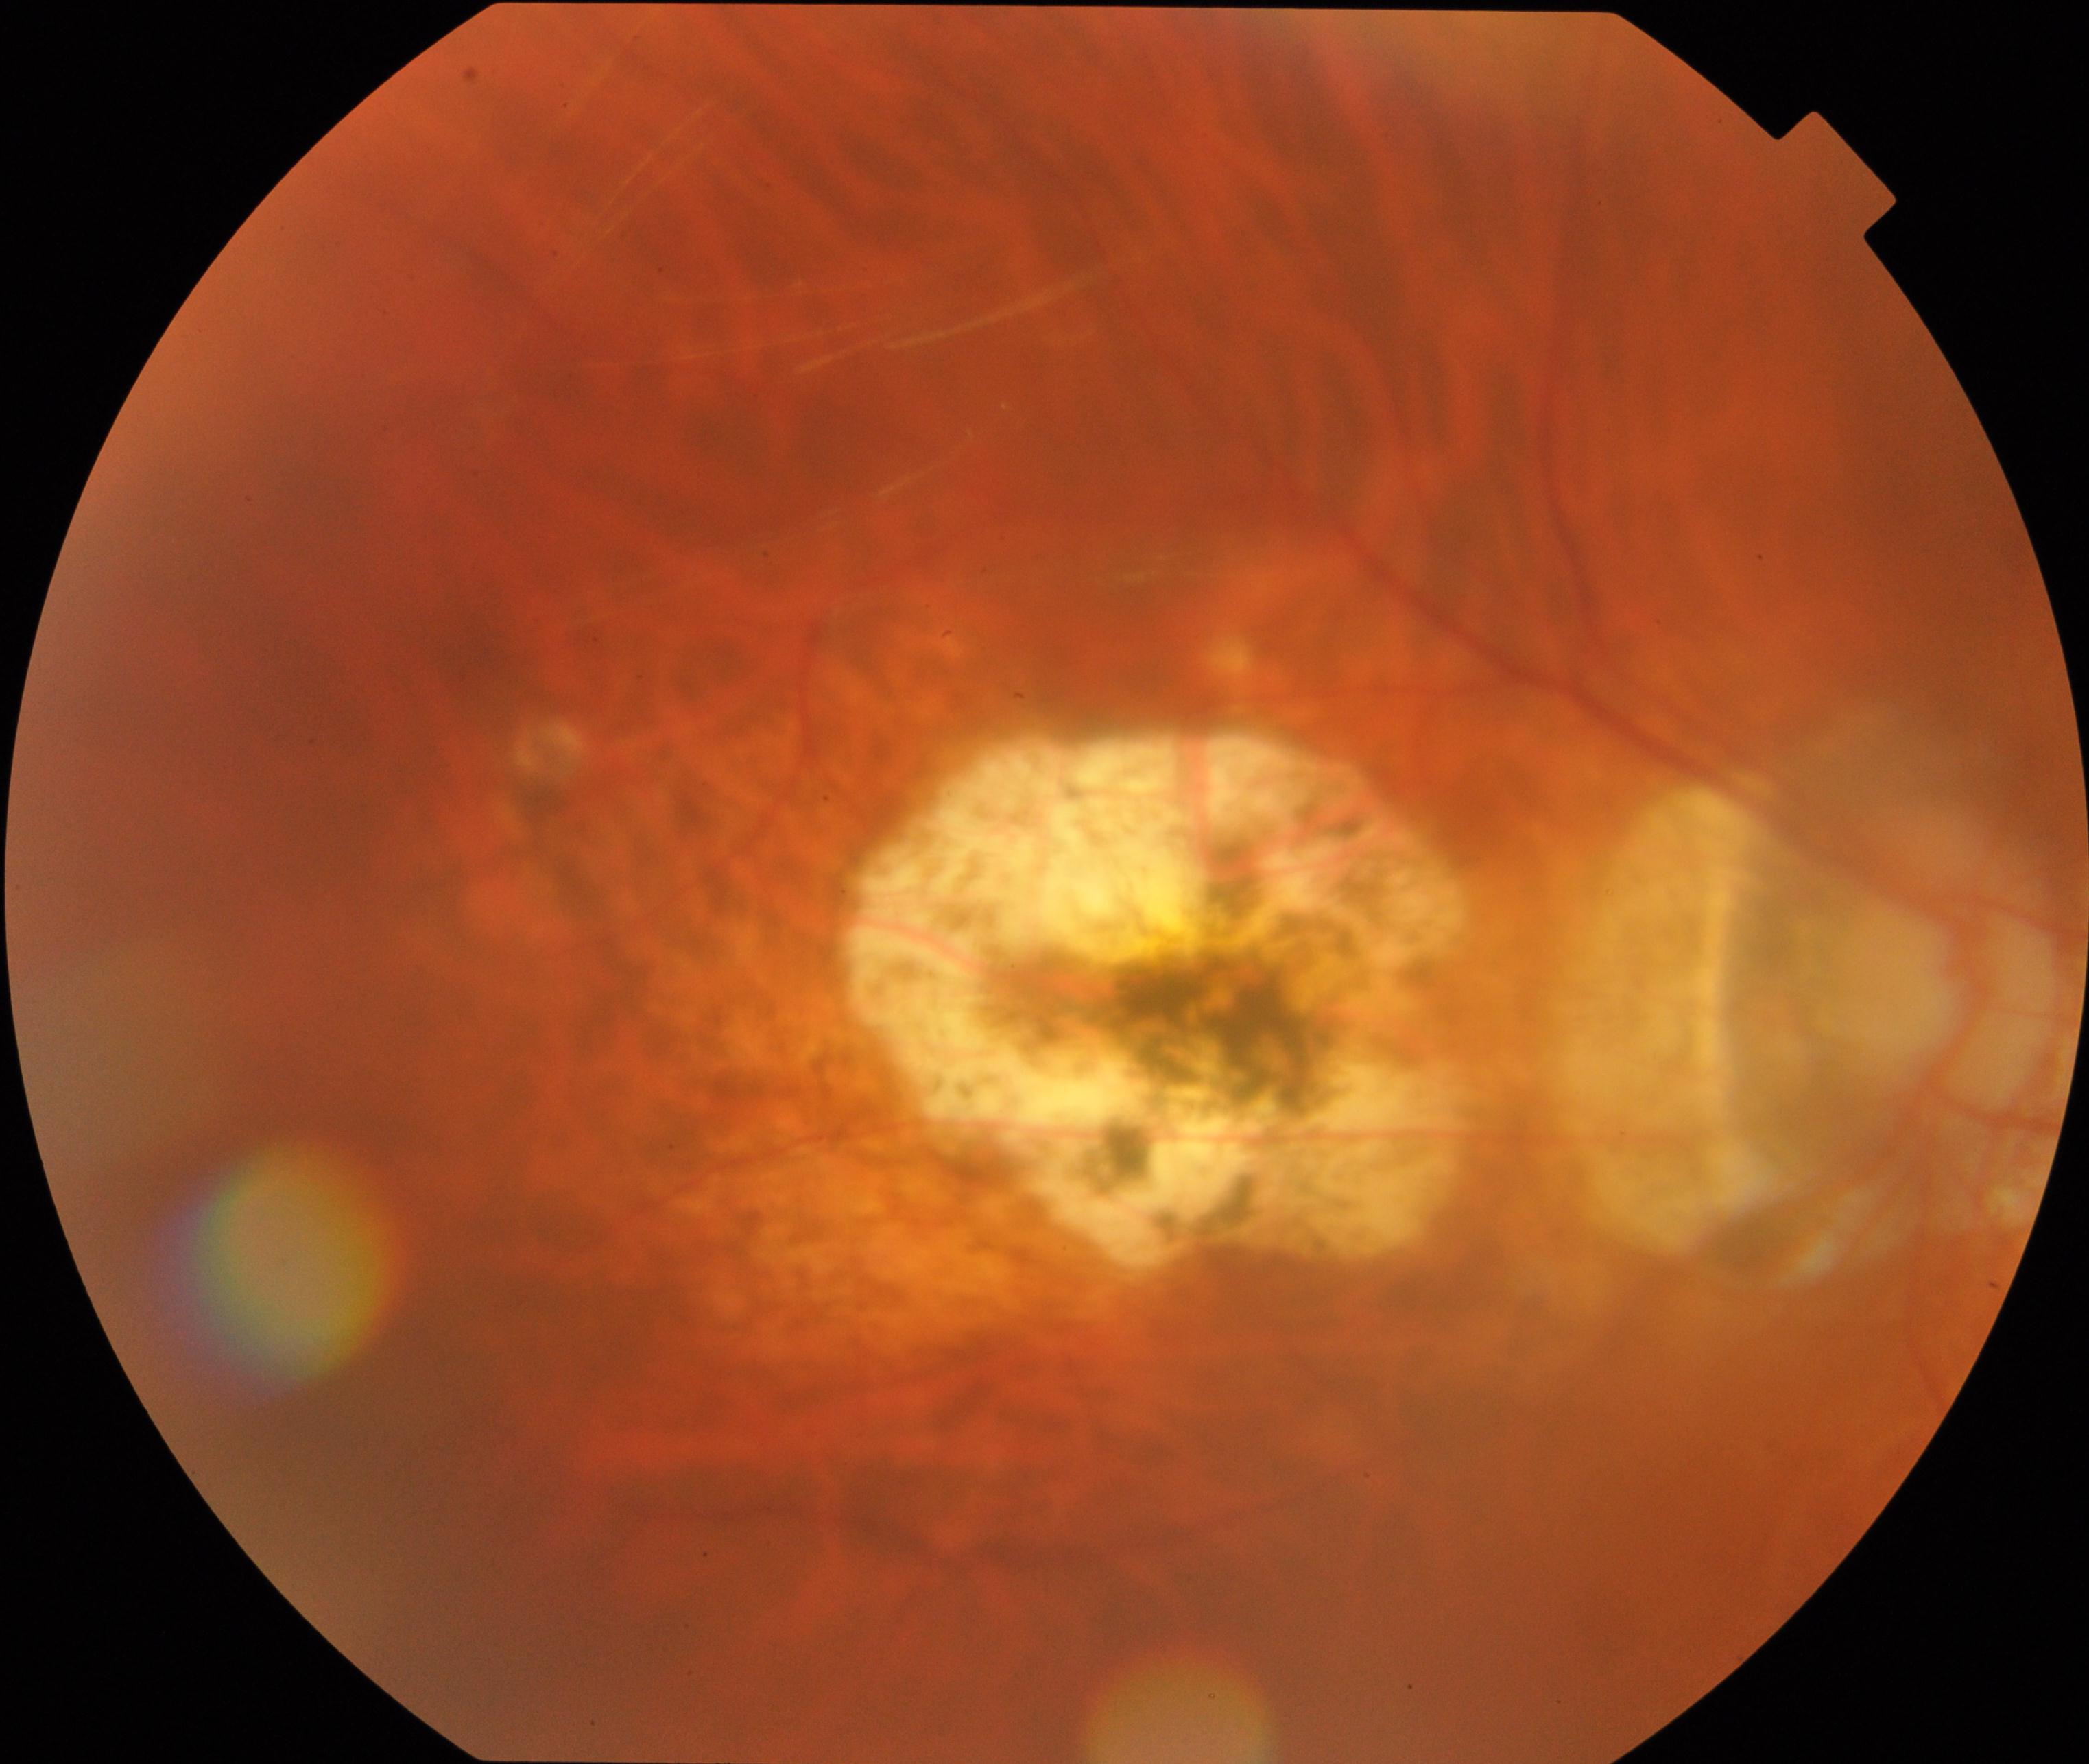 Impression: pathological myopia.